Image size 640x480. Wide-field fundus photograph from neonatal ROP screening — 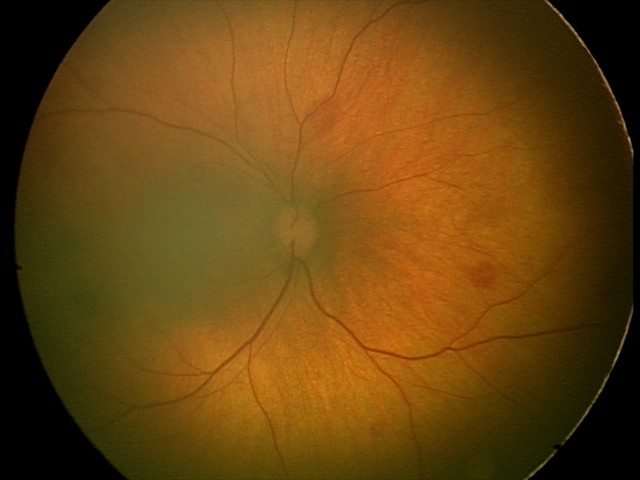
Screening examination consistent with retinal hemorrhages.